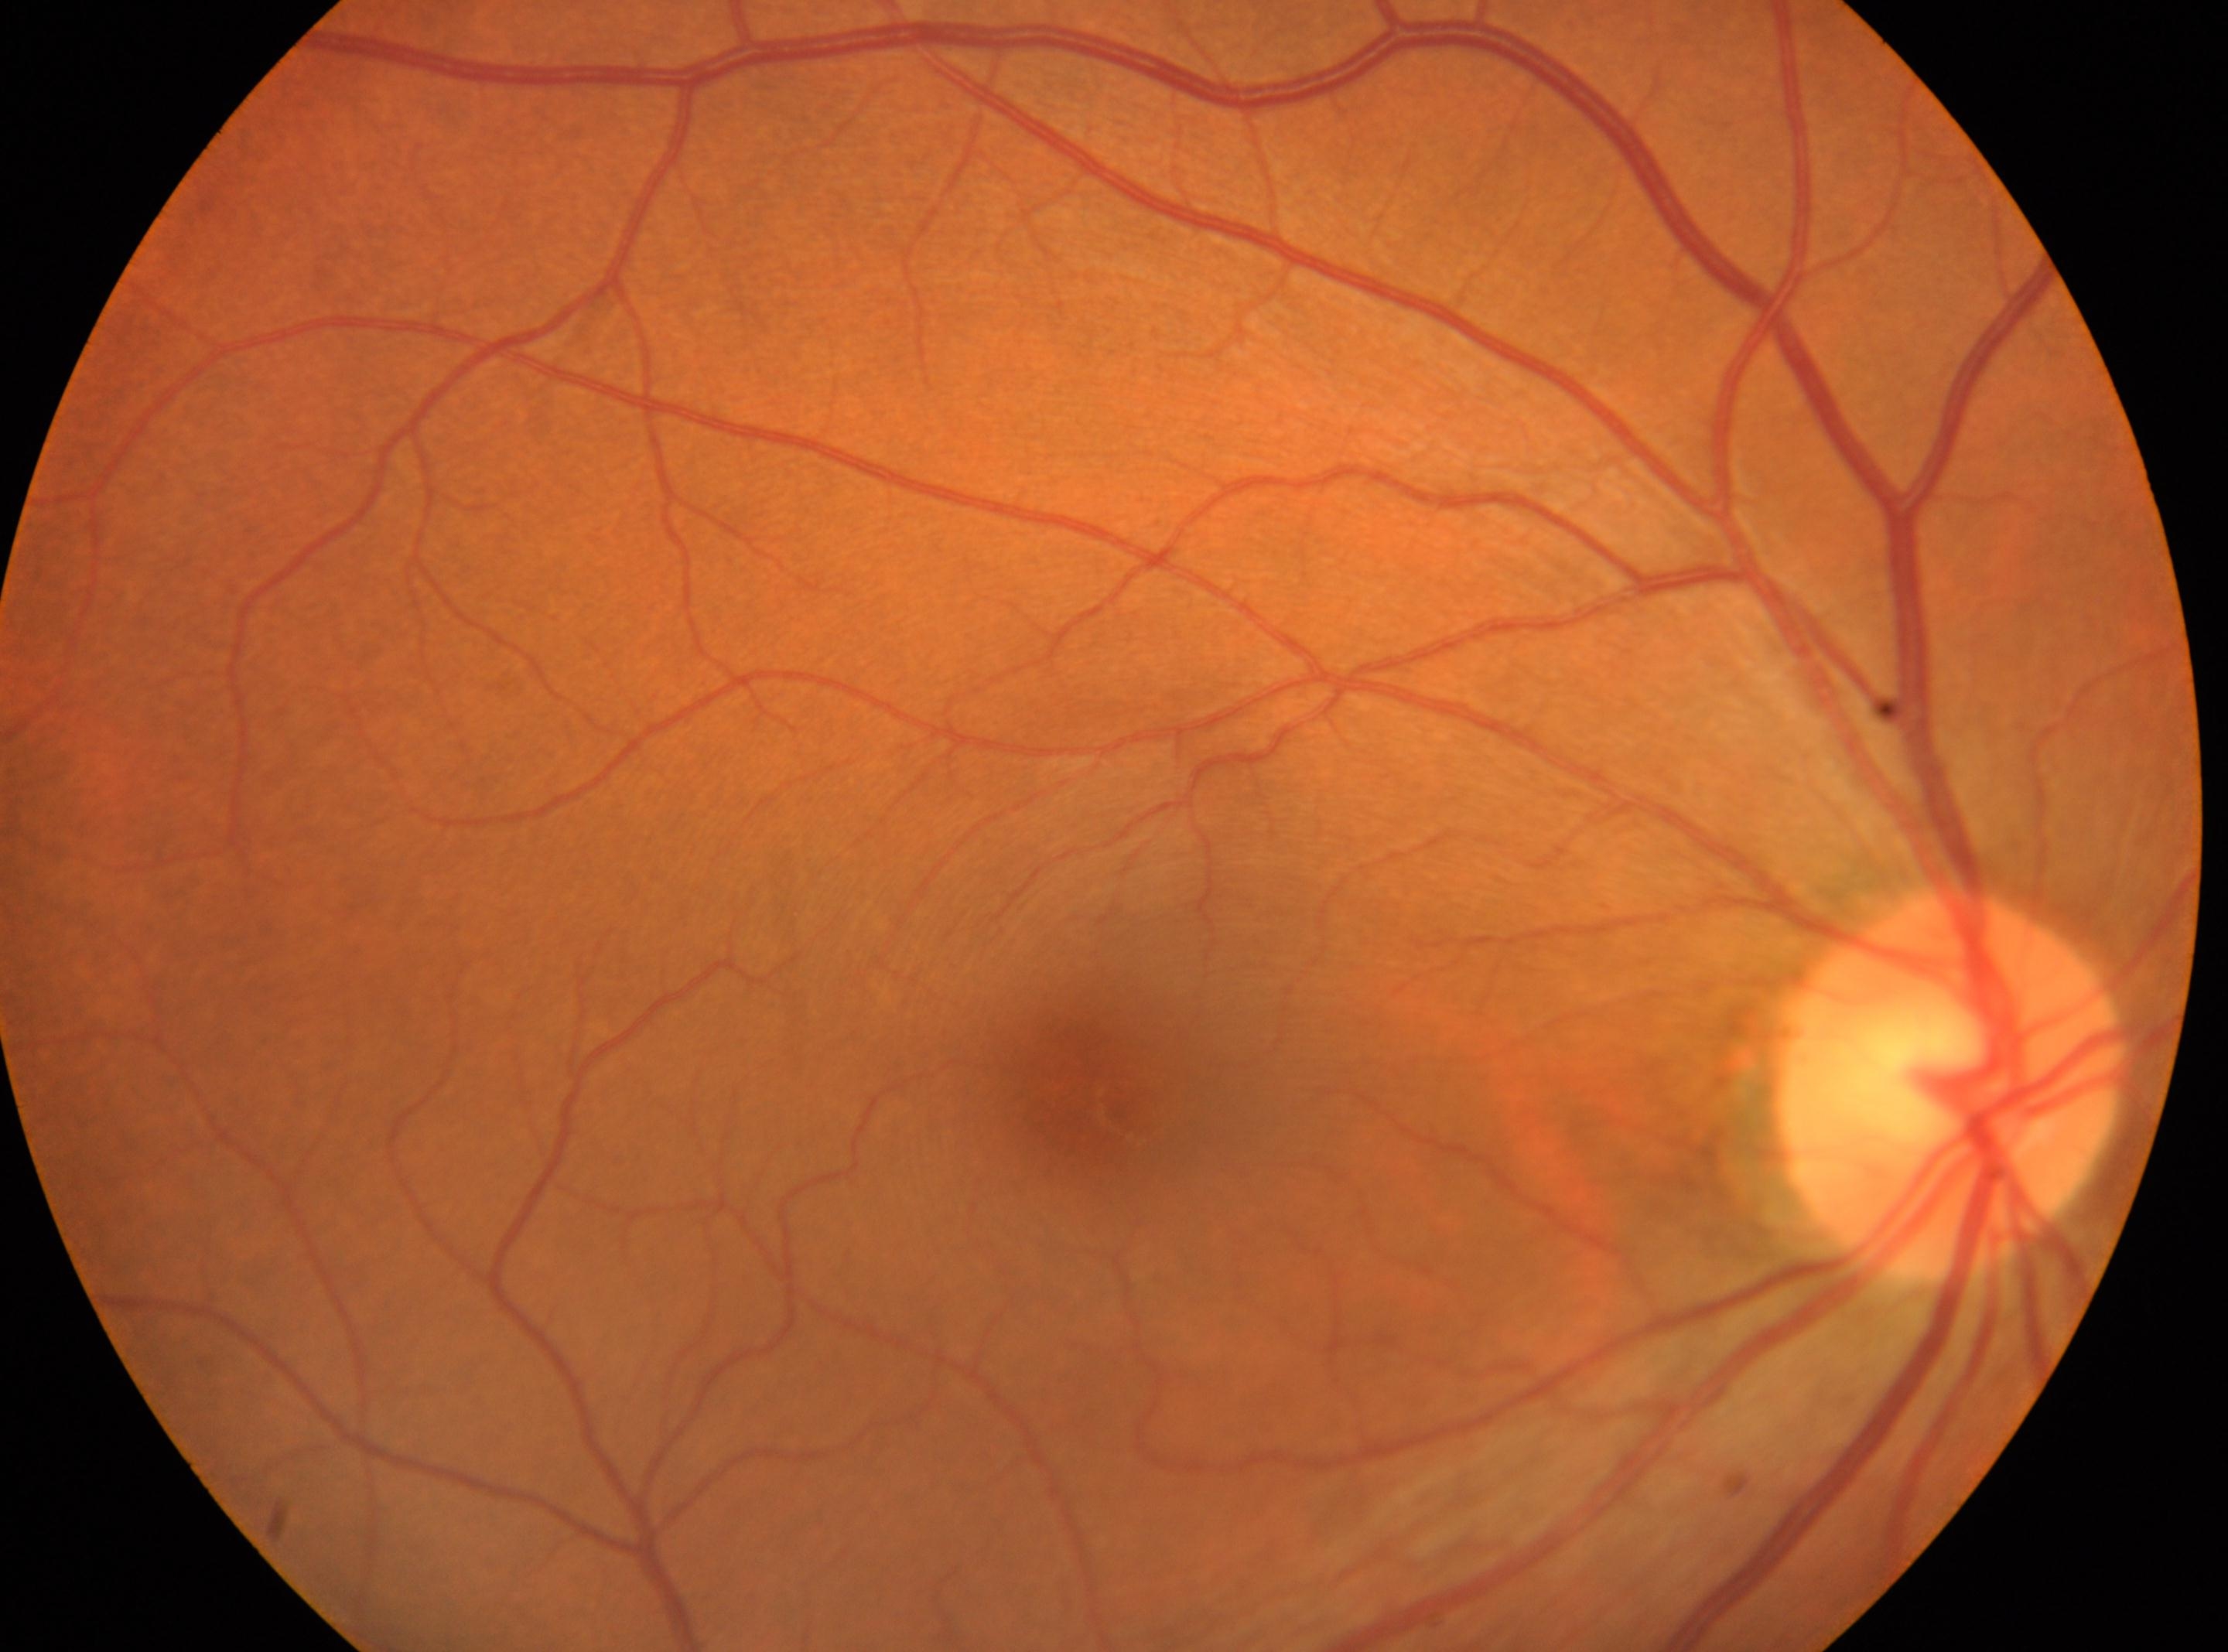
Q: Optic disc center?
A: (1950,1083)
Q: Which eye is imaged?
A: right eye
Q: Diabetic retinopathy severity?
A: 0
Q: Locate the fovea.
A: (1080,1087)